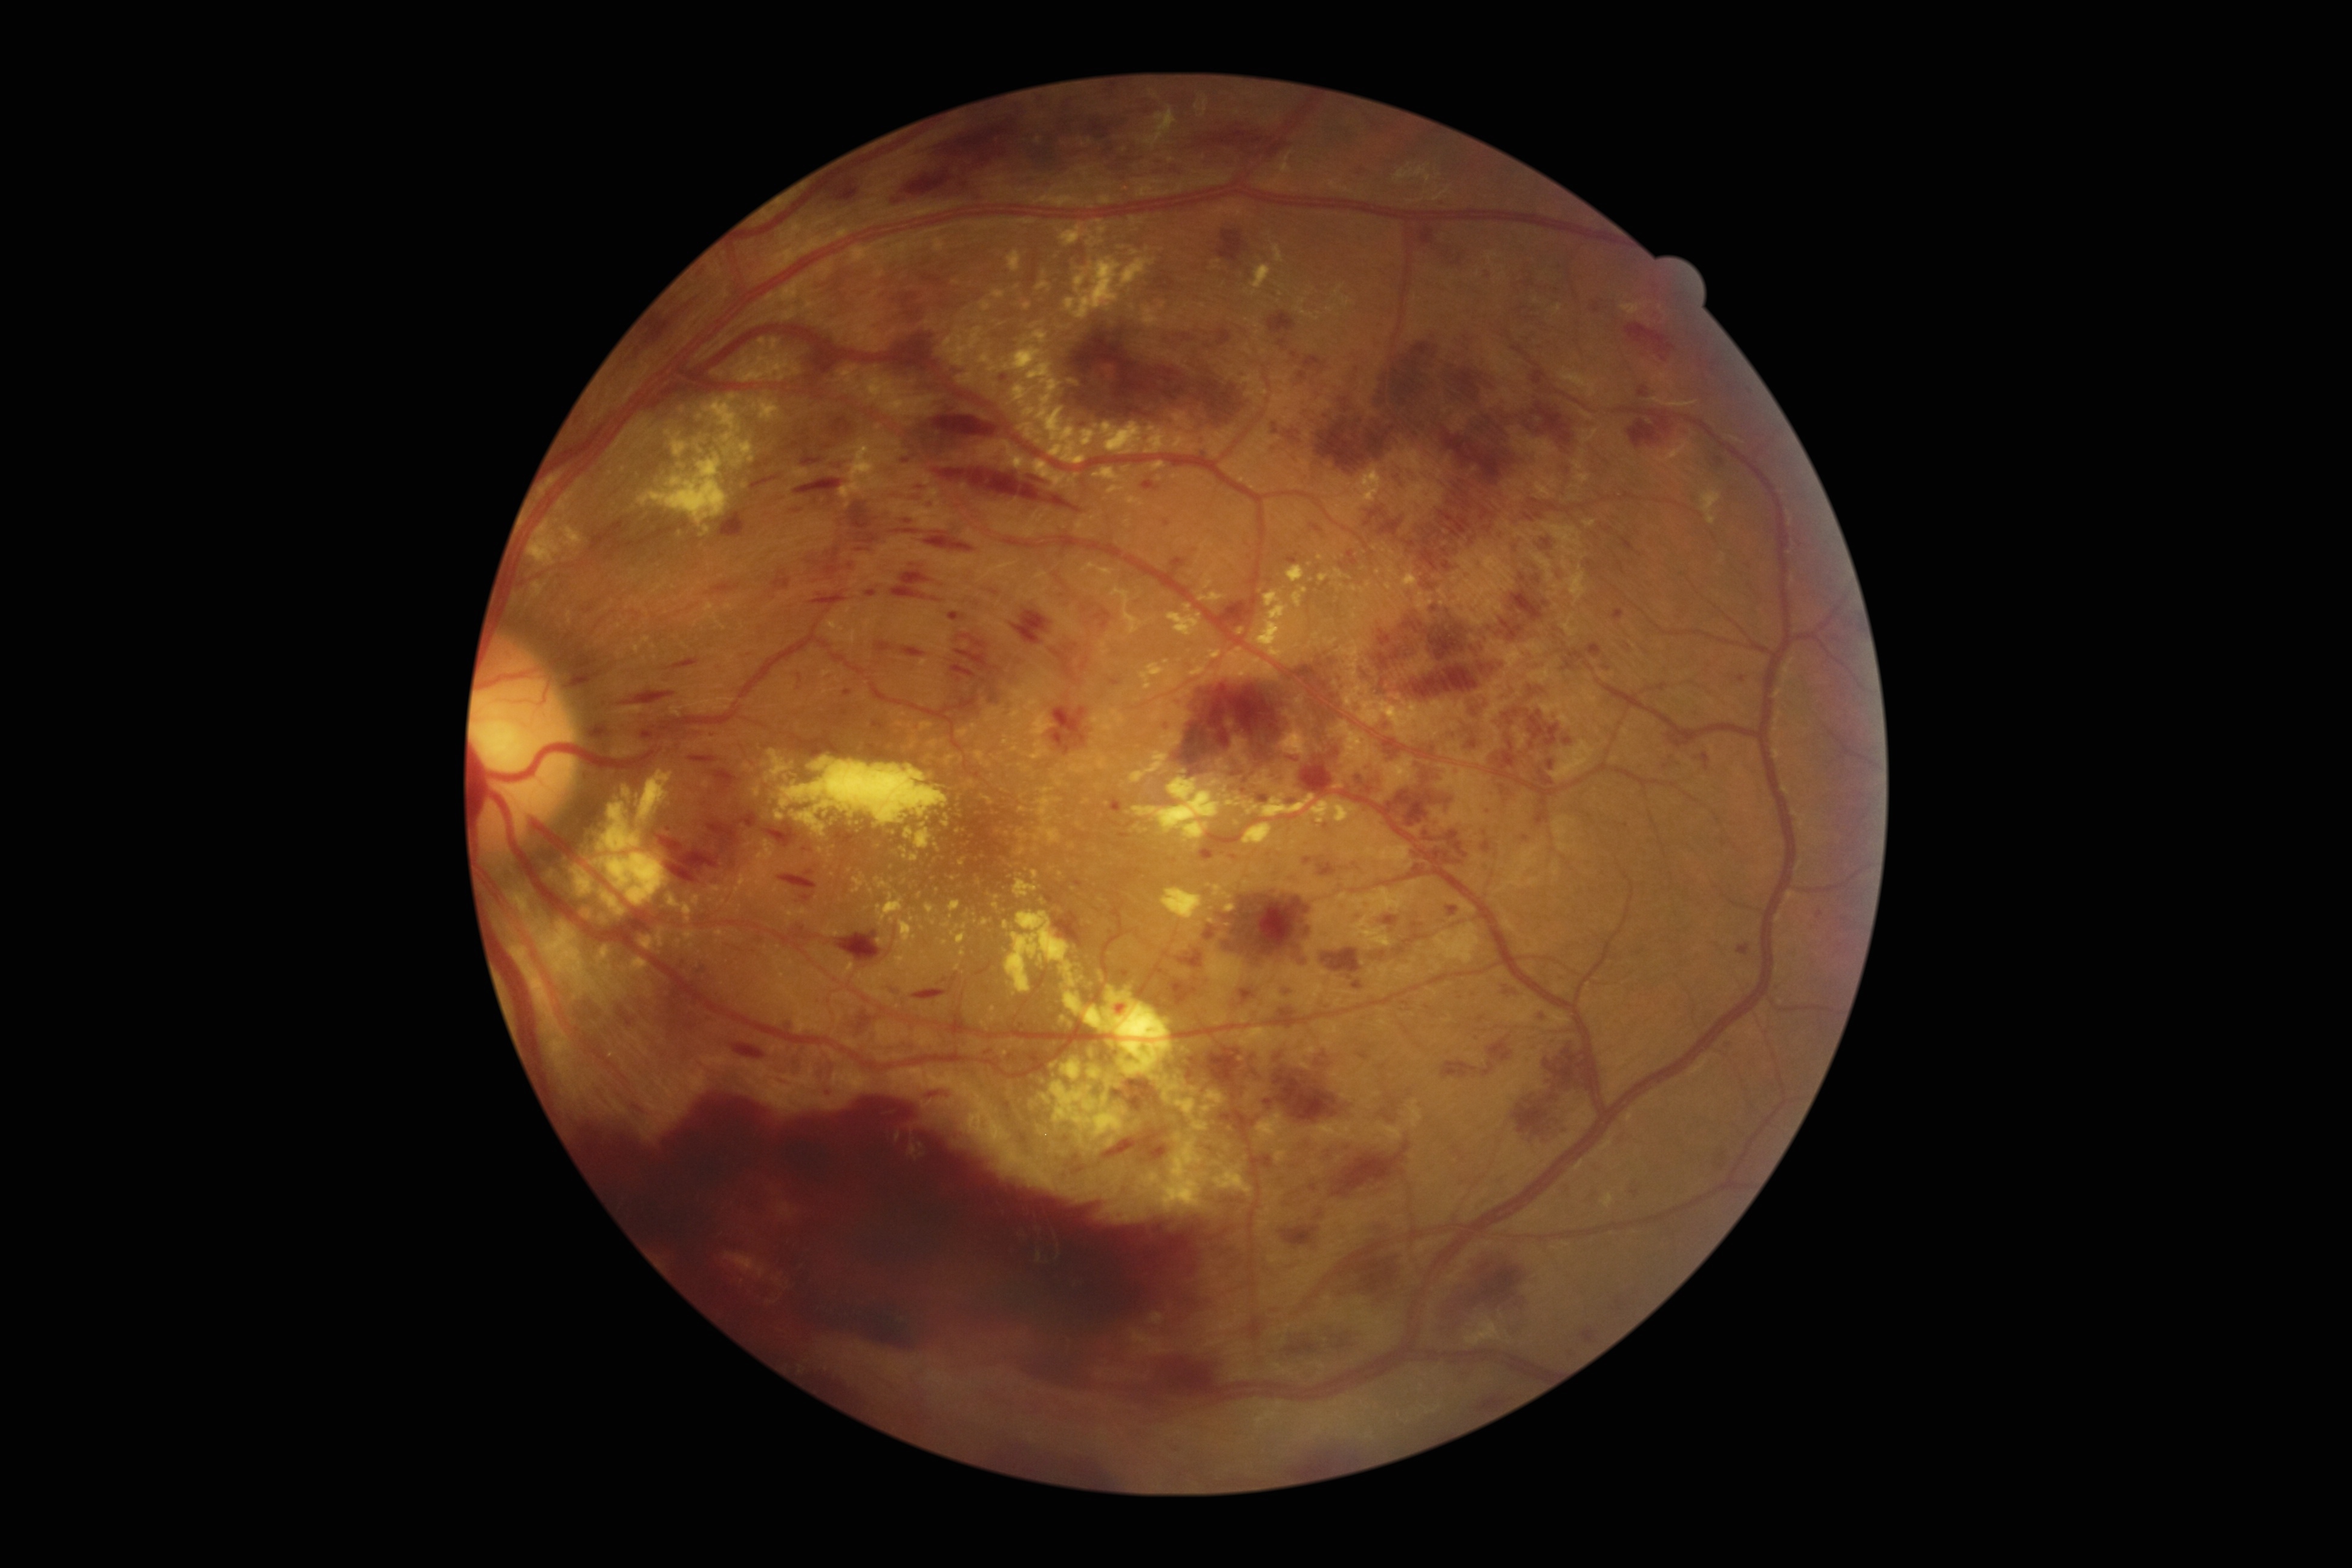
{"dr_category": "proliferative diabetic retinopathy", "dr_grade": "PDR (grade 4) — neovascularization and/or vitreous/pre-retinal hemorrhage"}